Modified Davis grading; fundus photo: 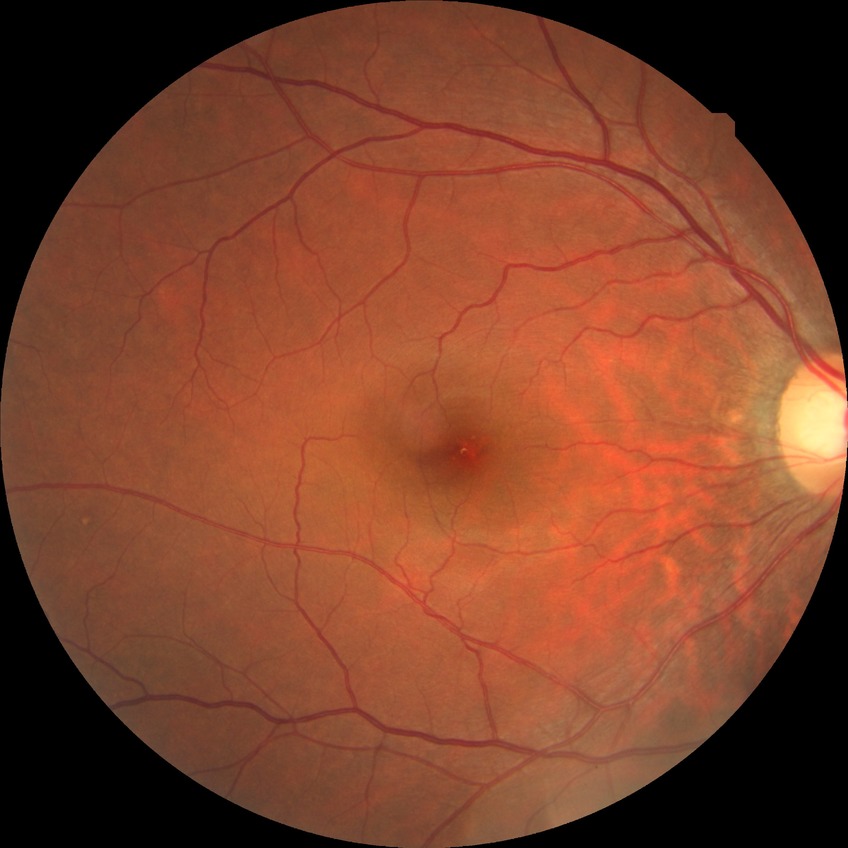
diabetic retinopathy (DR)@no diabetic retinopathy (NDR).